Image size 1659x2212, retinal fundus photograph — 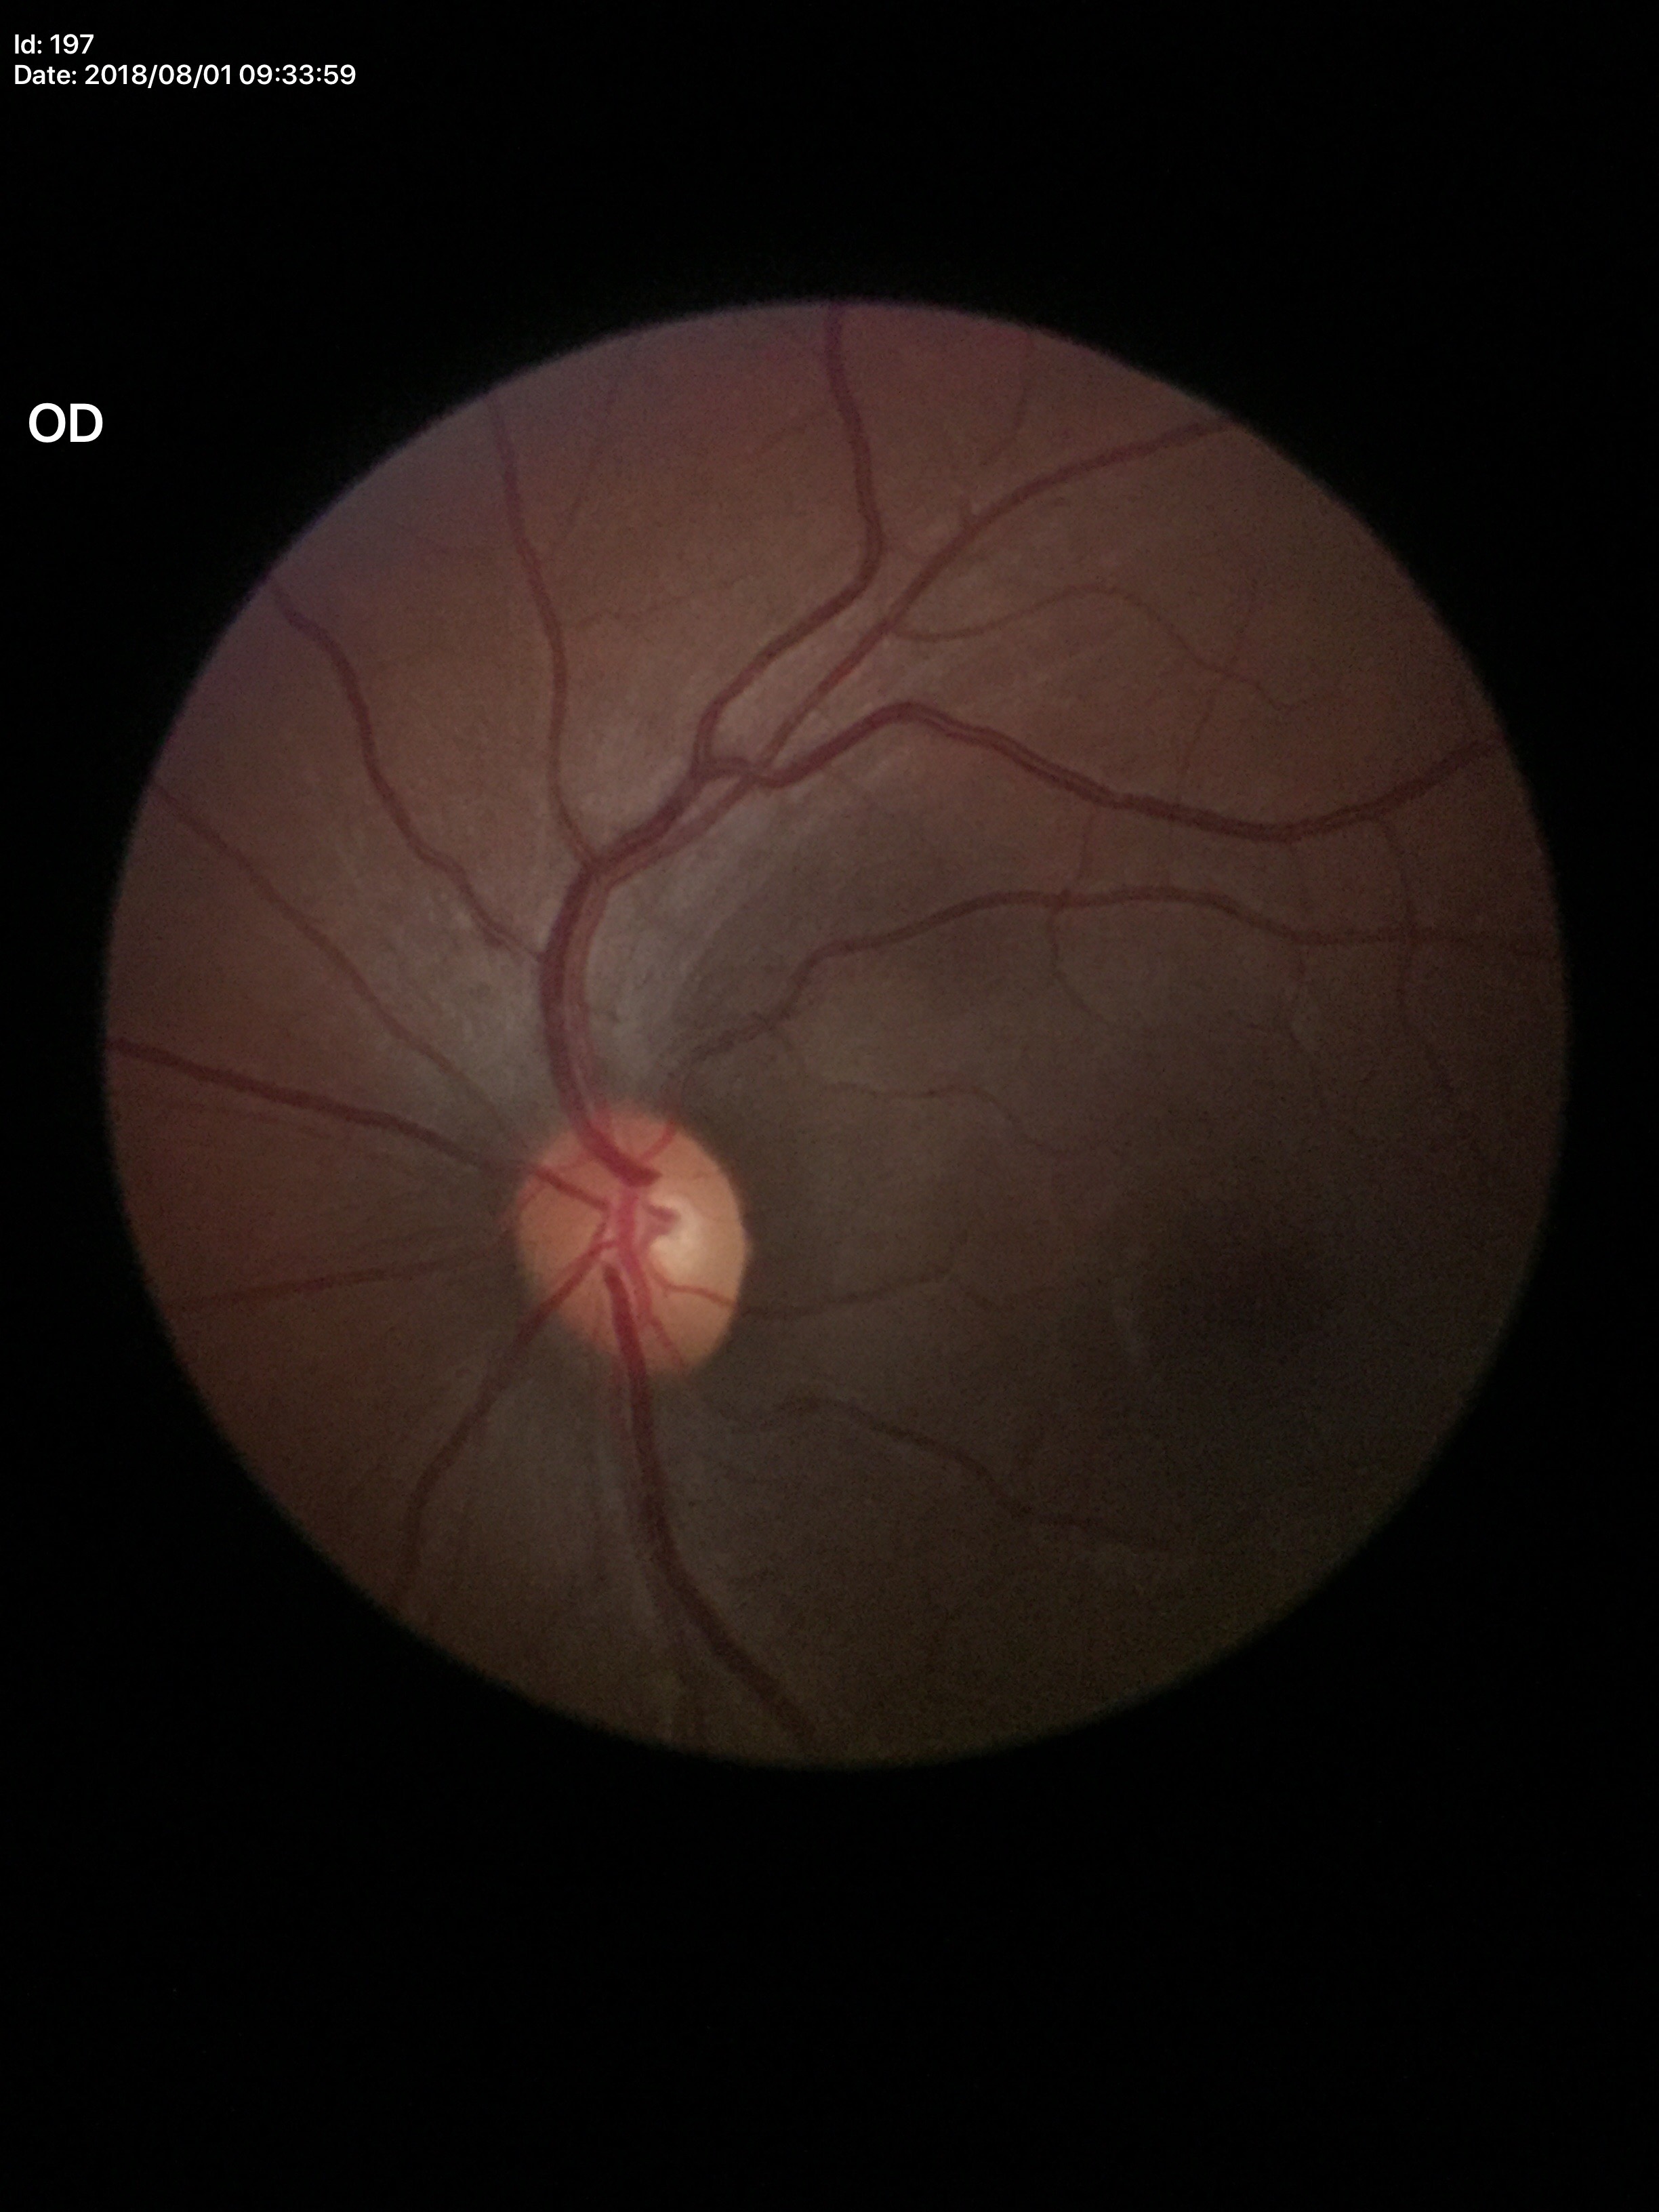

Annotations:
• Glaucoma decision · negative
• horizontal C/D ratio · 0.54
• area CDR · 0.26
• vertical CDR · 0.49